Pediatric wide-field fundus photograph. 1440 x 1080 pixels:
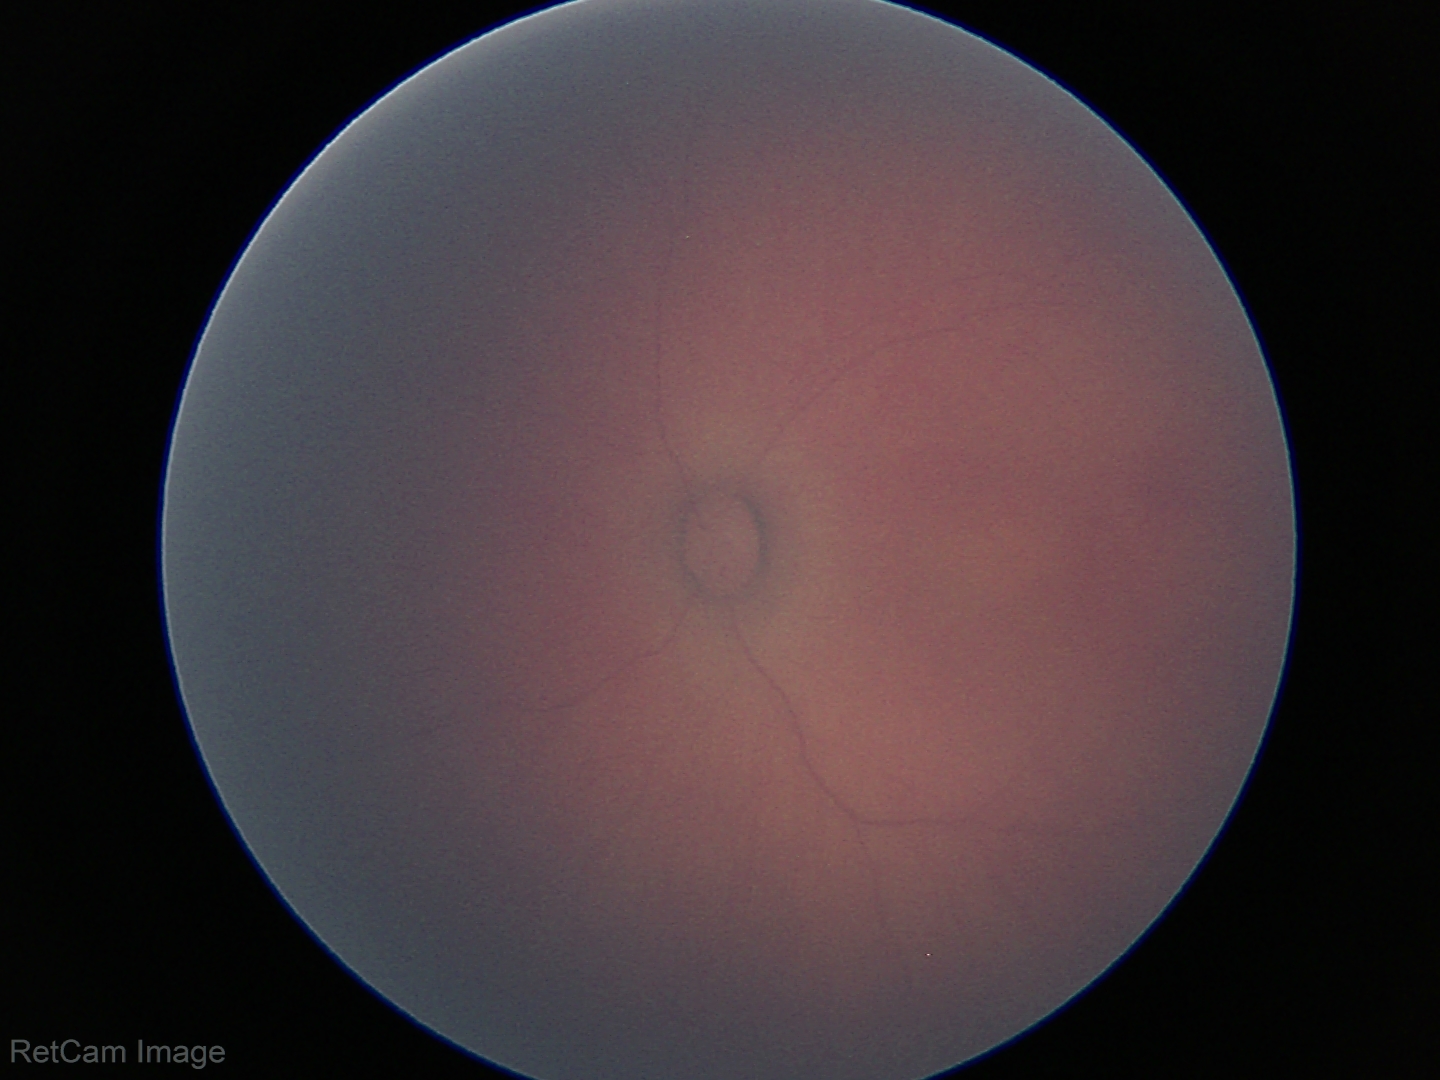

Screening examination with no abnormal retinal findings.